NIDEK AFC-230: 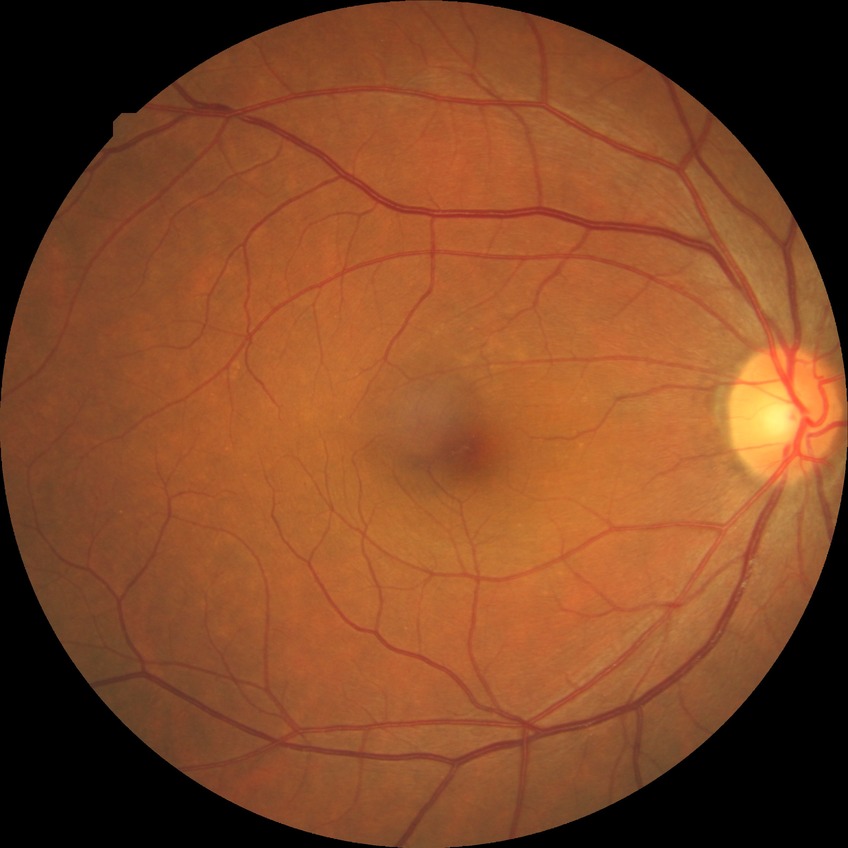

diabetic retinopathy (DR): NDR (no diabetic retinopathy).